Color fundus photograph, 45° field of view, 2352 x 1568 pixels — 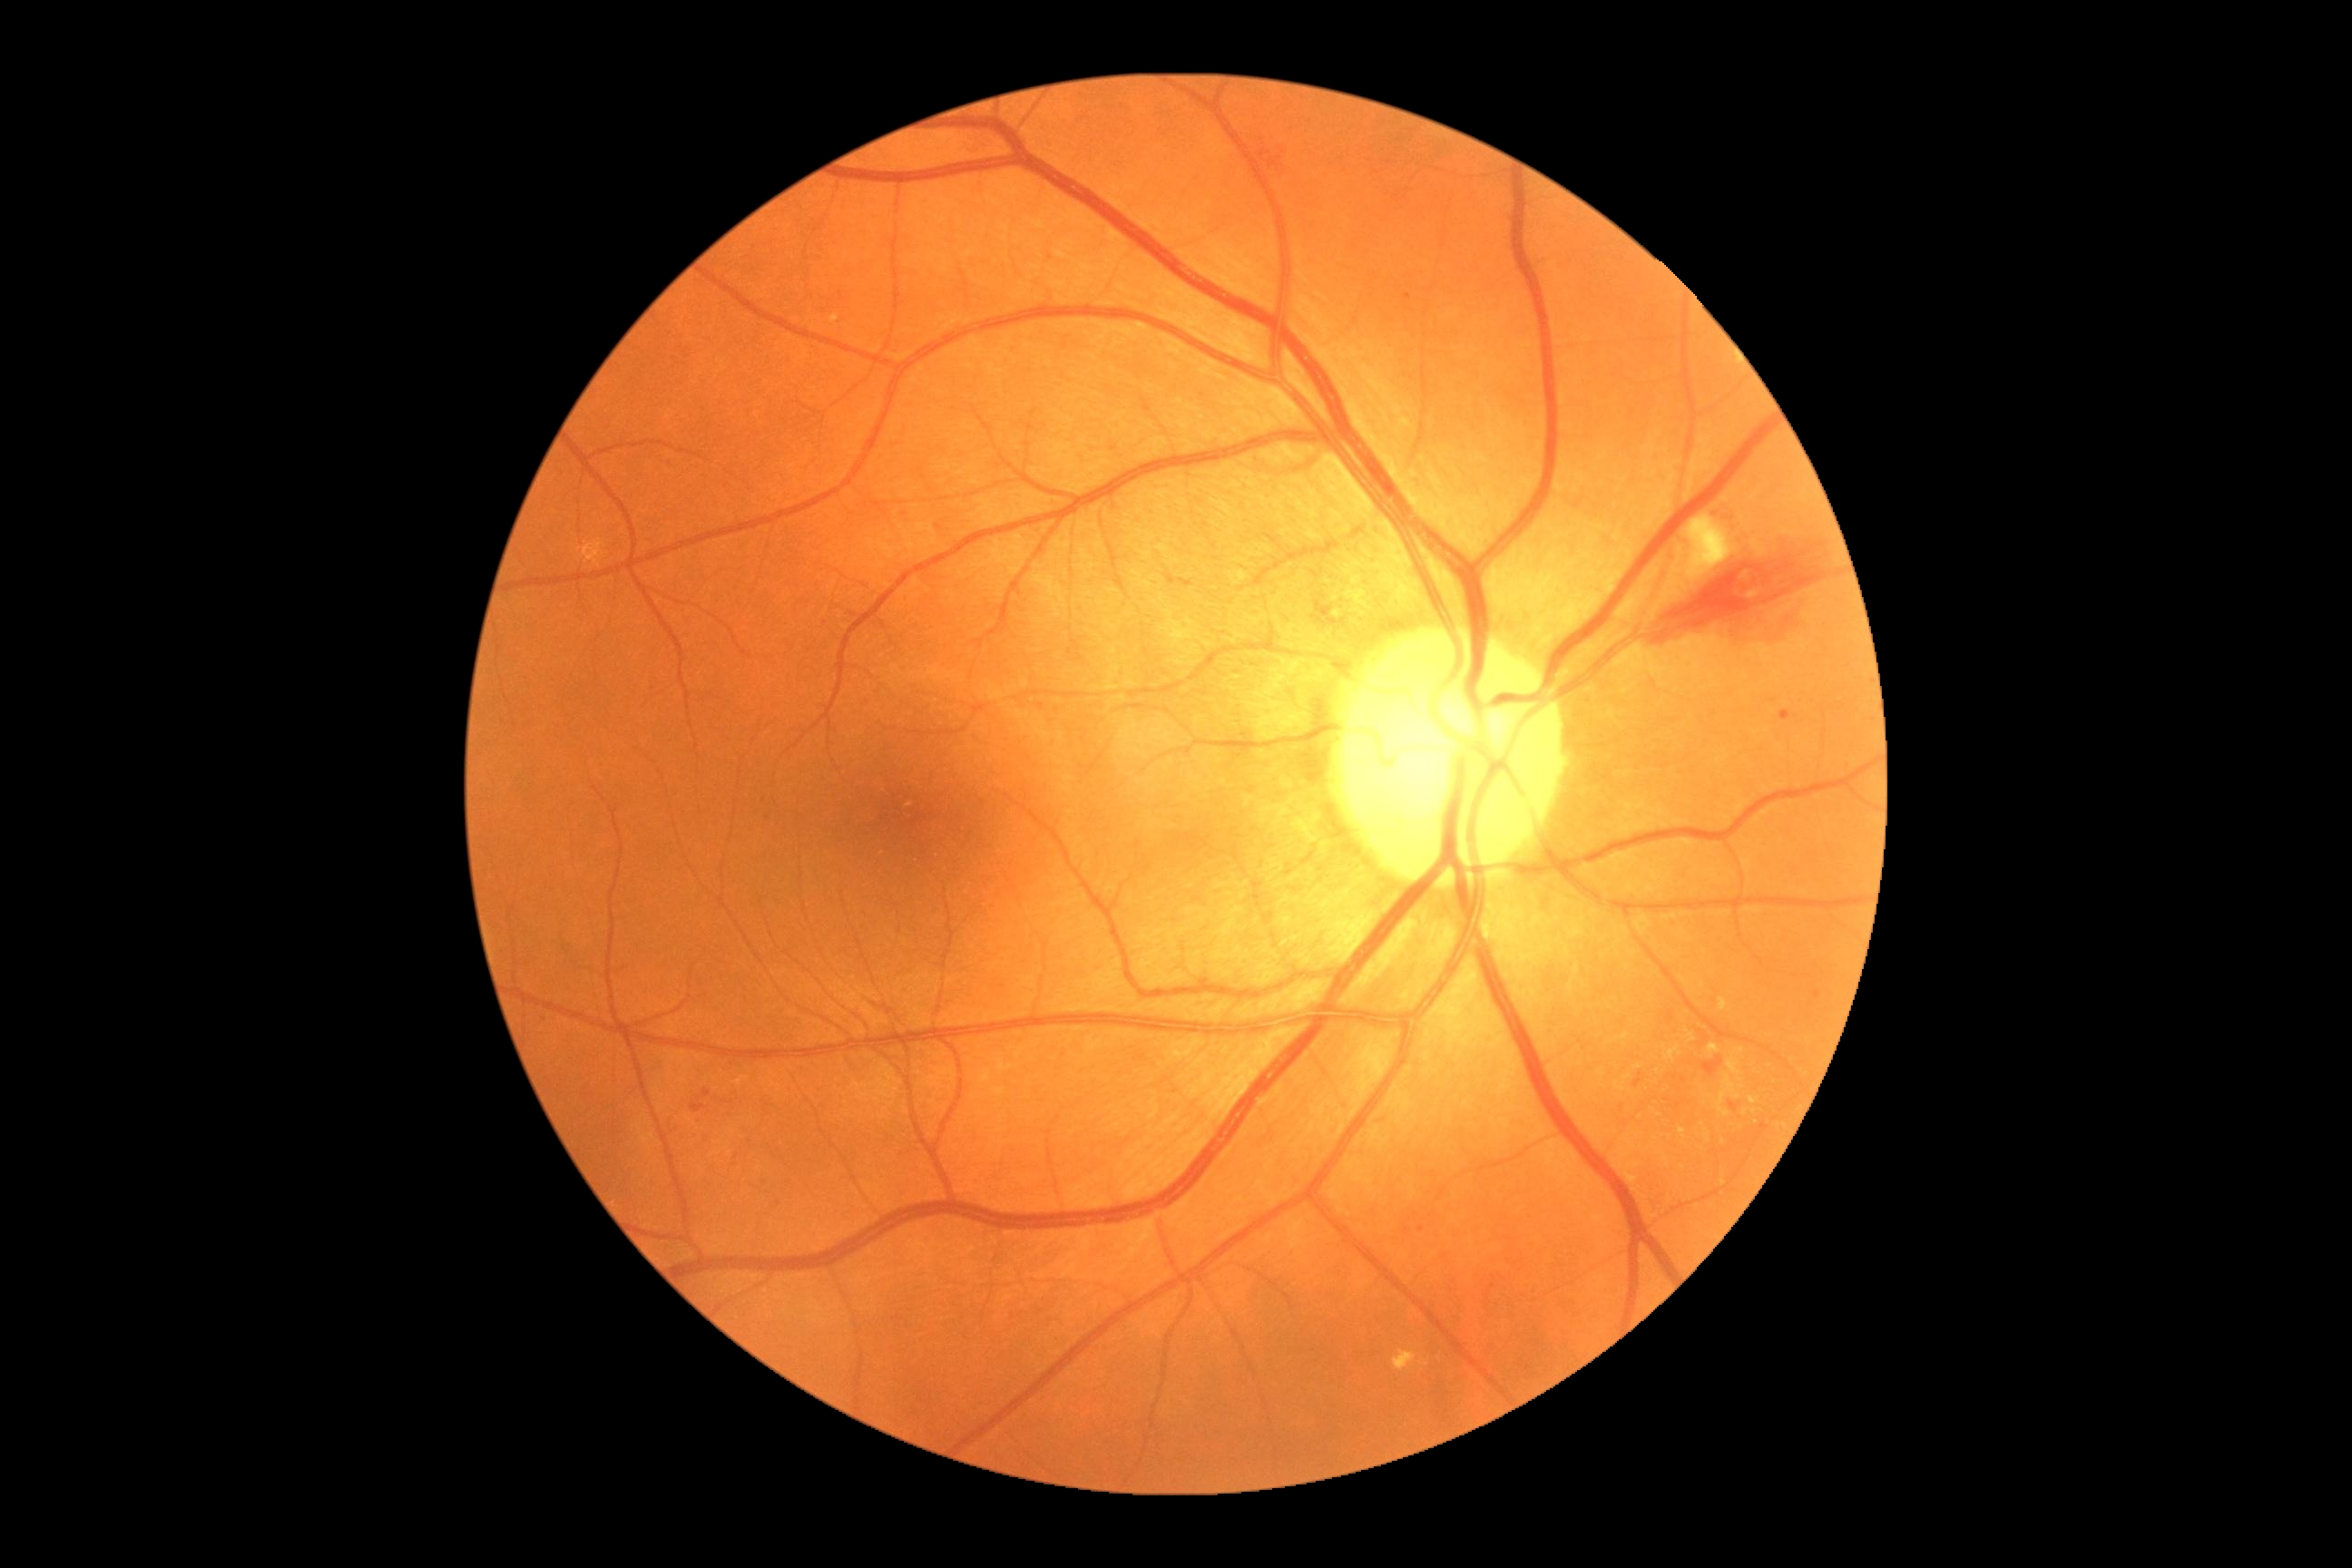

DR grade: moderate non-proliferative diabetic retinopathy (2)
Selected lesions:
HEs (continued): 1703, 1057, 1723, 1077; 1166, 574, 1177, 585; 1248, 130, 1289, 179; 1418, 1228, 1426, 1233; 1179, 578, 1193, 589; 691, 1102, 709, 1113; 1634, 1079, 1643, 1088; 1761, 1124, 1769, 1132
Small HEs near <pt>1407,296</pt>; <pt>939,527</pt>; <pt>1674,1079</pt>